848 by 848 pixels.
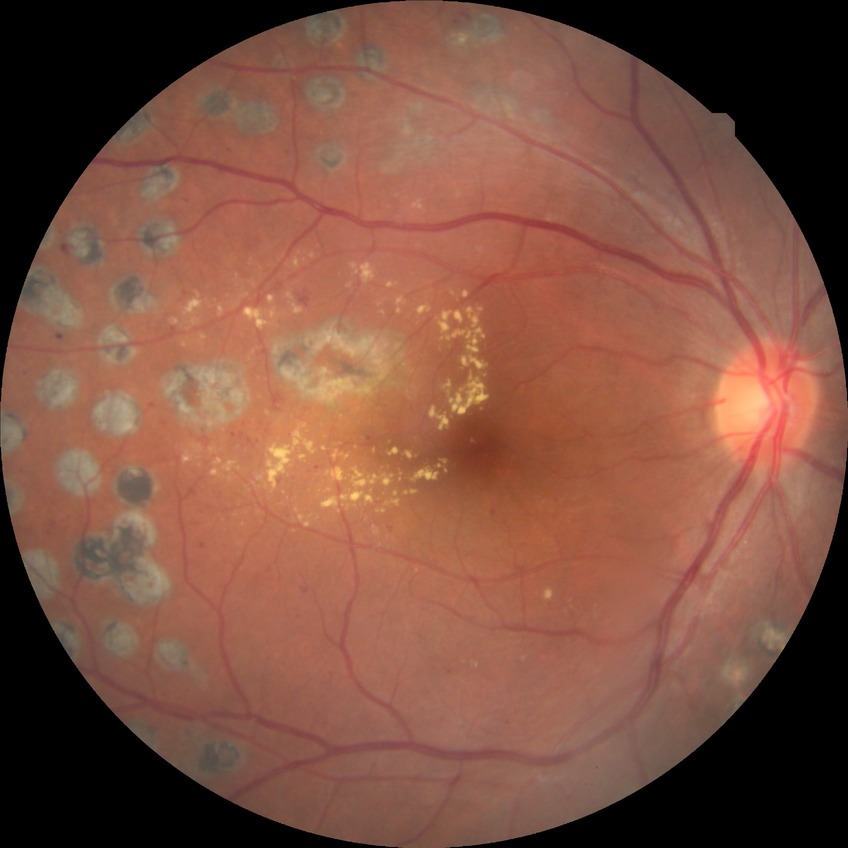

Assessment:
– modified Davis classification: proliferative diabetic retinopathy